Image size 2352x1568. 45-degree field of view. Color fundus photograph
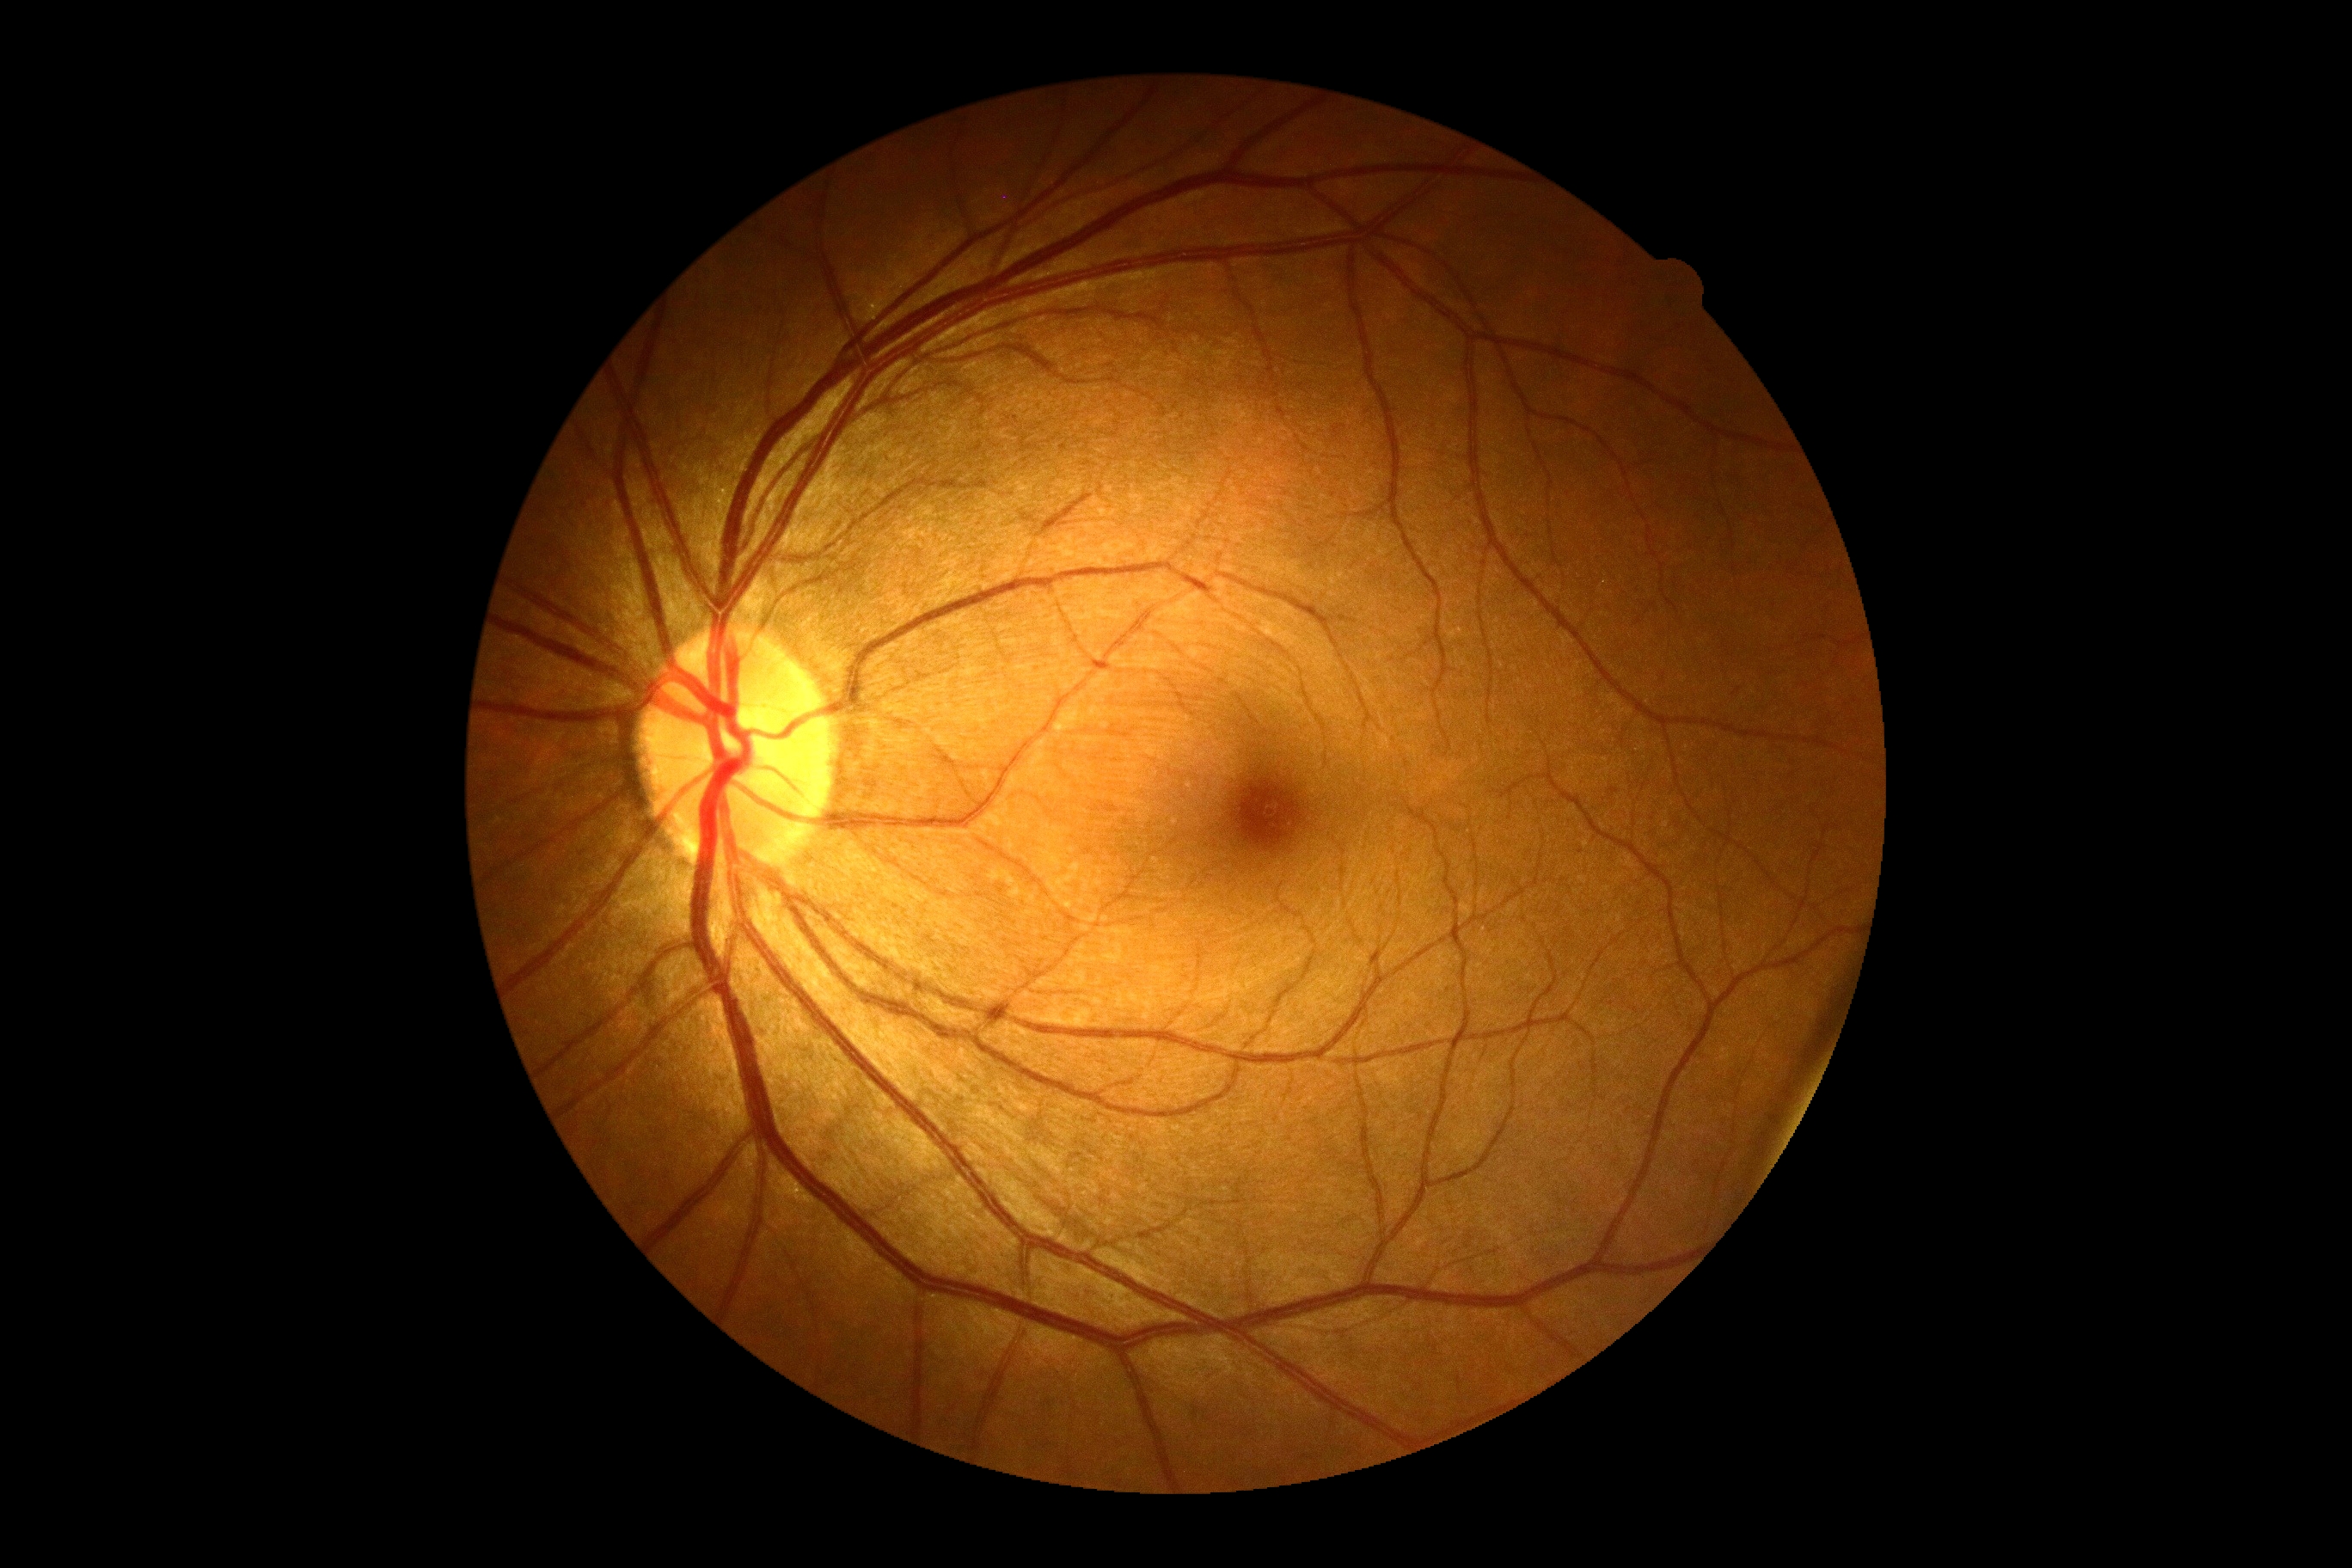

Retinopathy grade: 0/4.